Image size 2352x1568
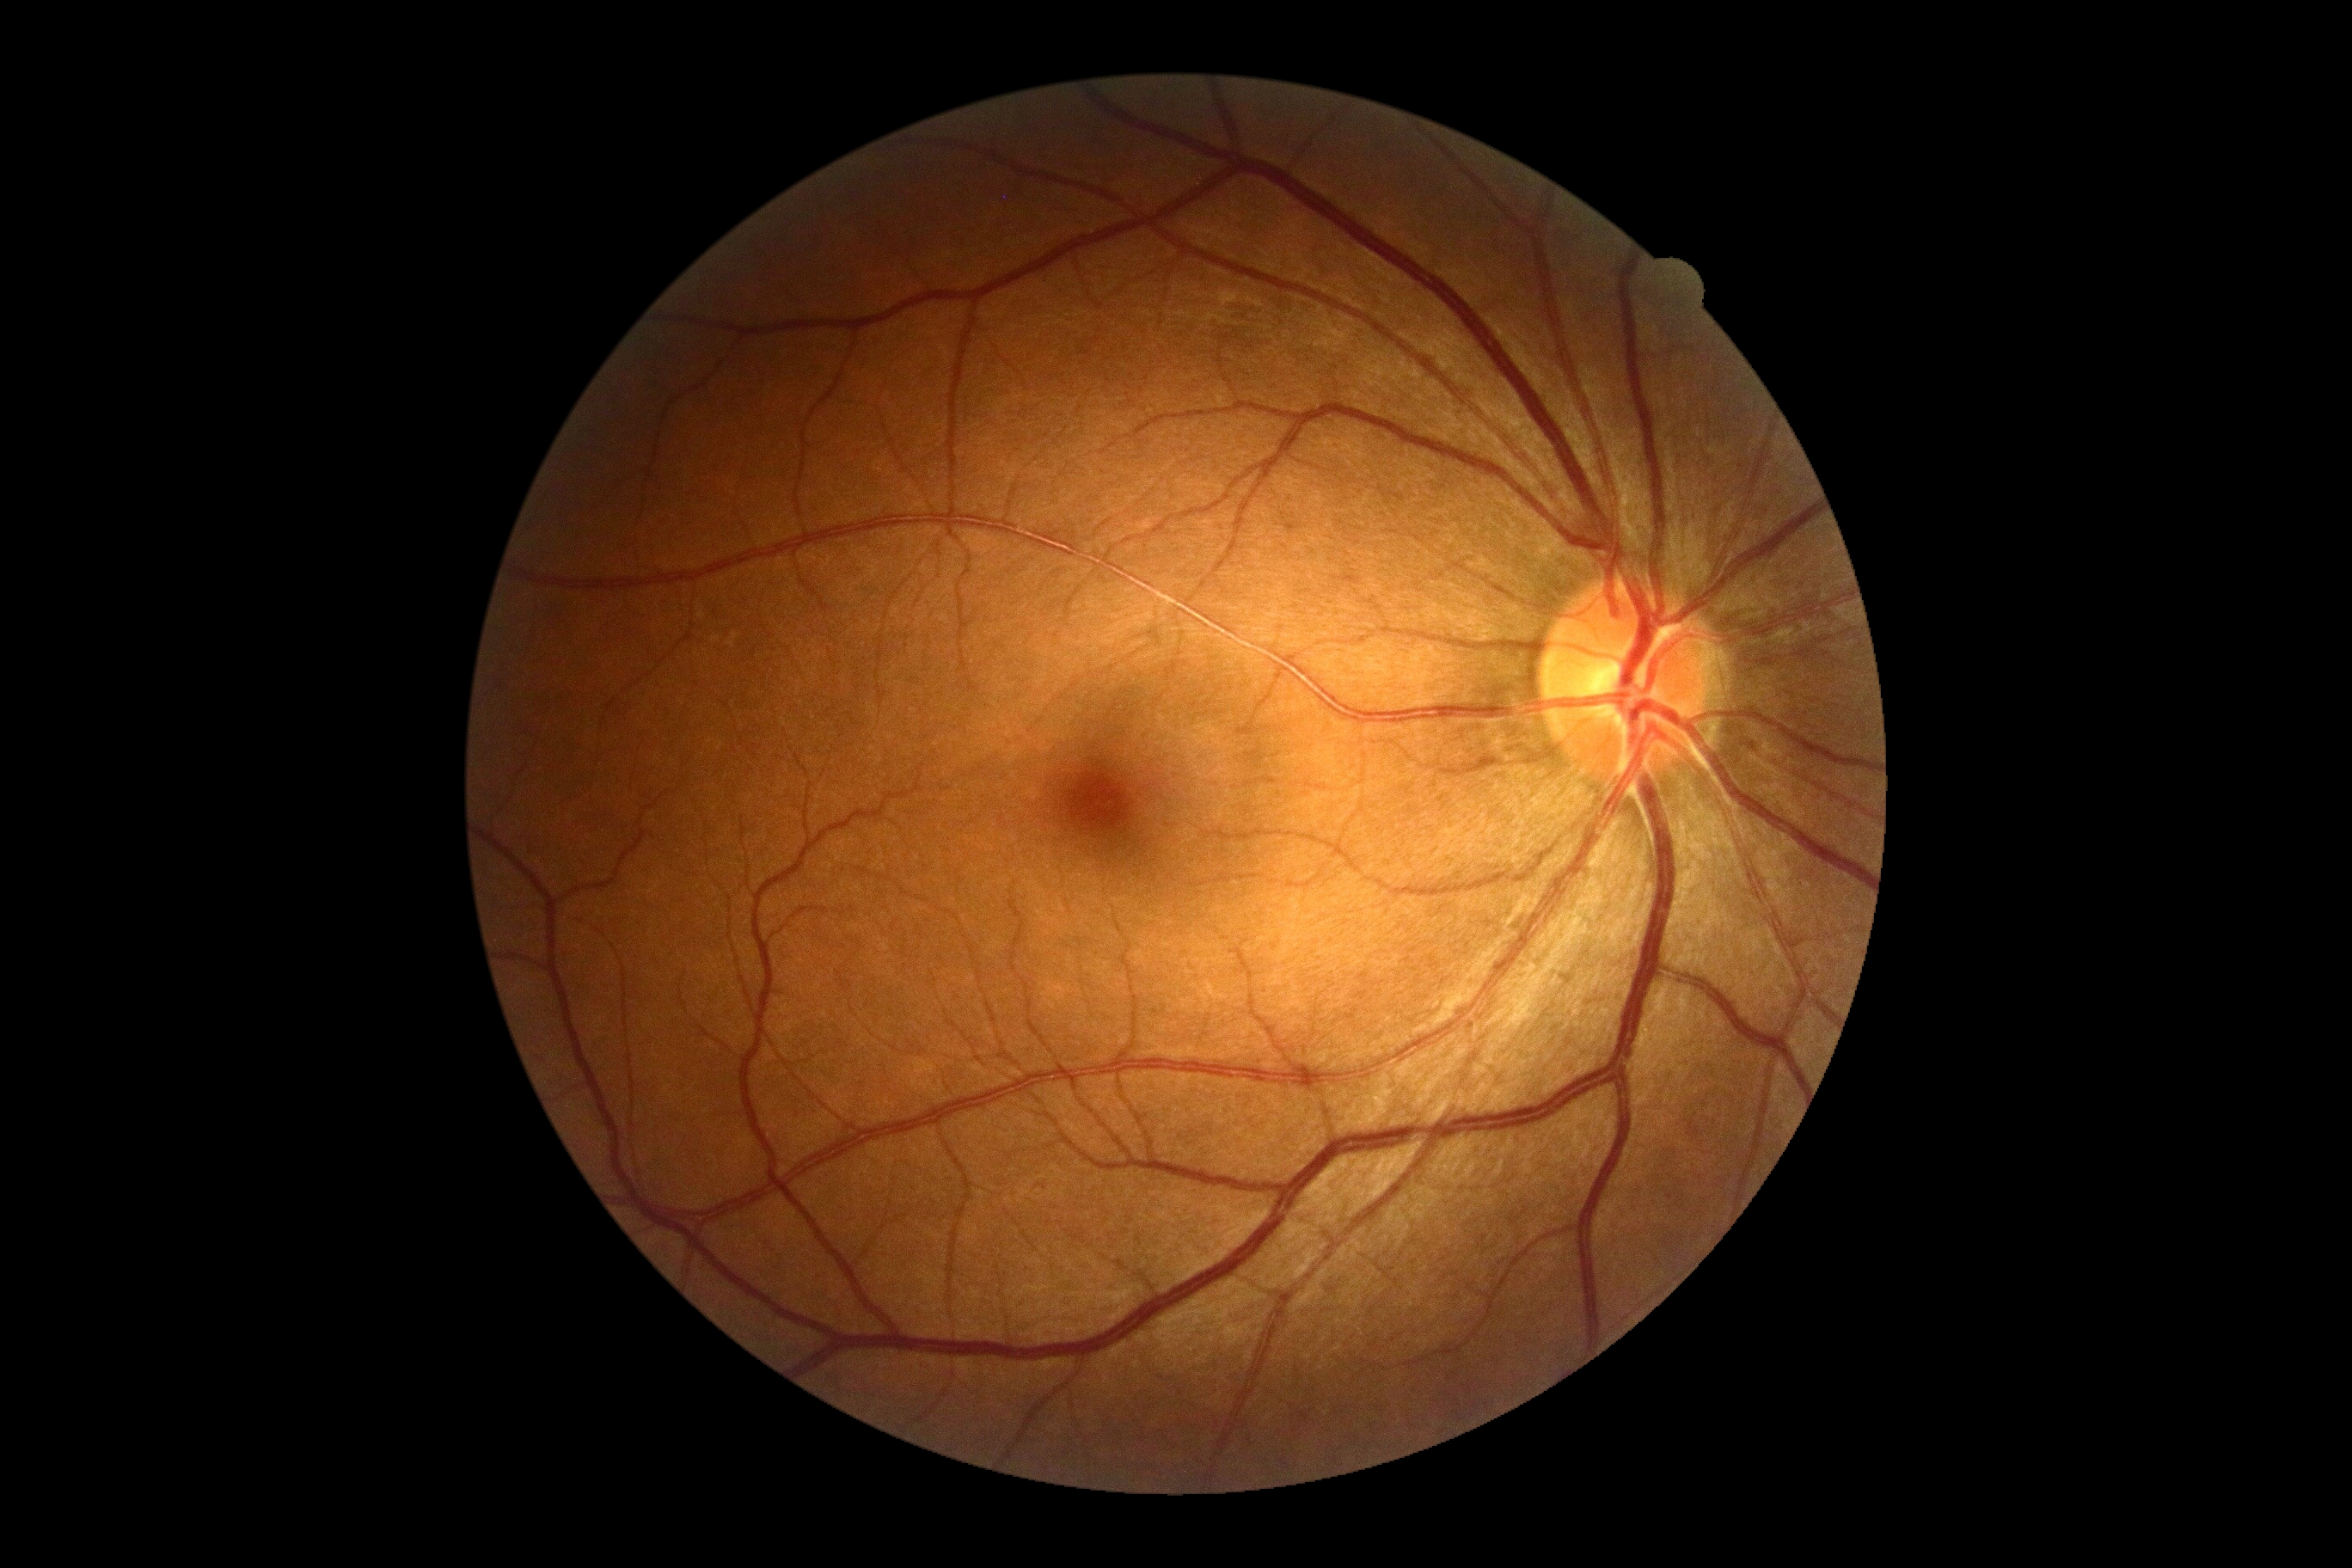 DR severity = grade 0